NIDEK AFC-230 fundus camera, 848 by 848 pixels, posterior pole color fundus photograph — 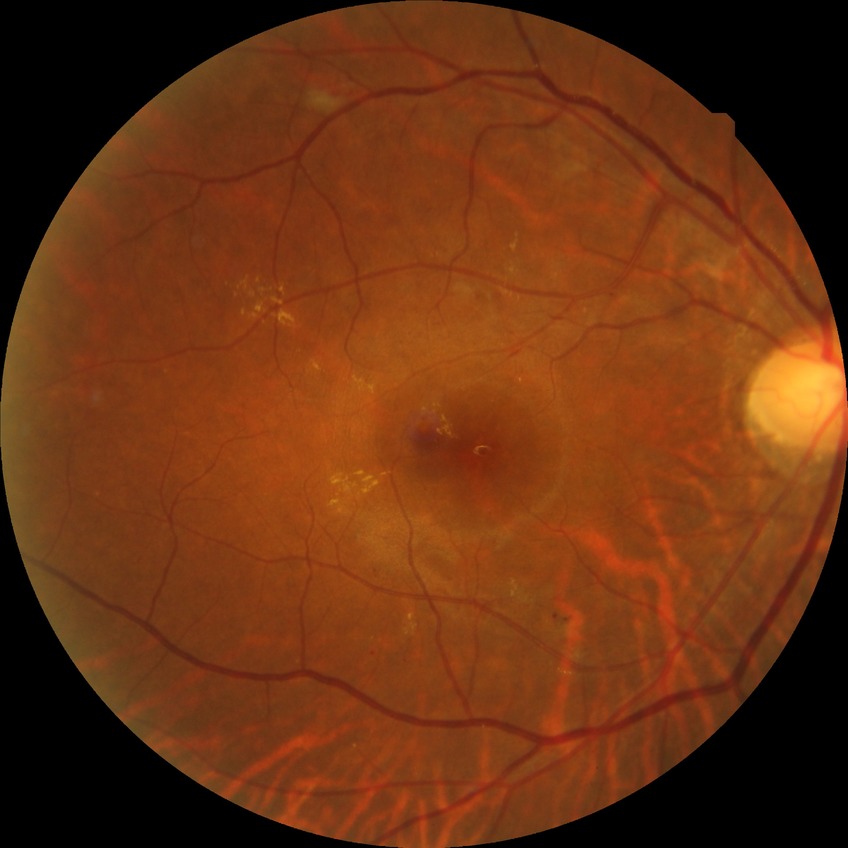

diabetic retinopathy (DR): PPDR (pre-proliferative diabetic retinopathy).